848 by 848 pixels; color fundus image.
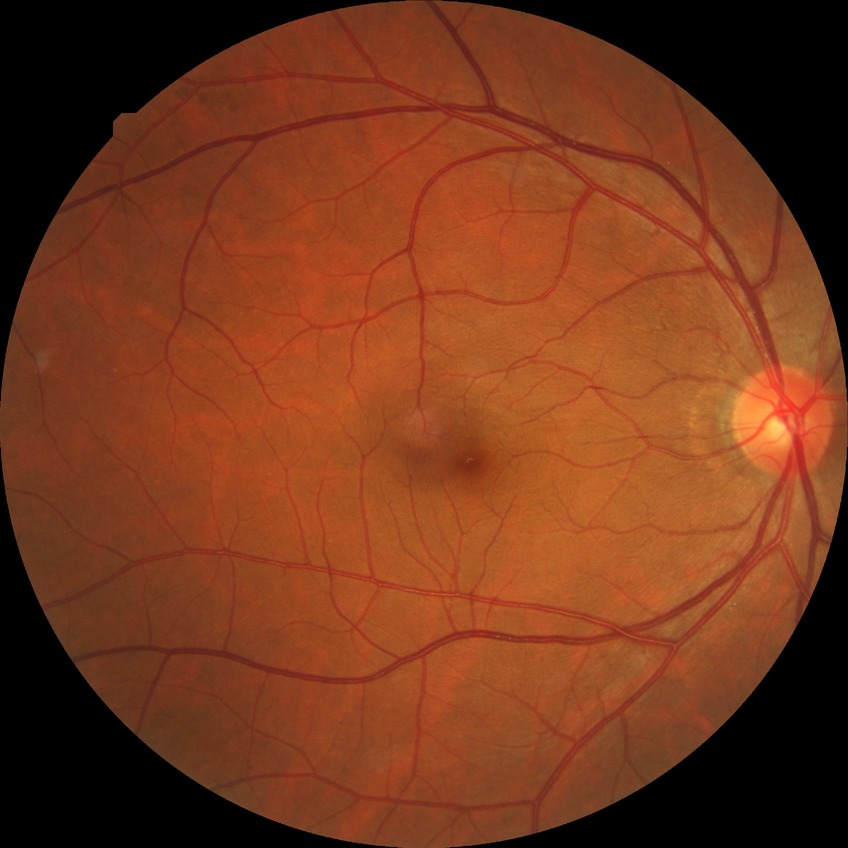
Diabetic retinopathy (DR): no diabetic retinopathy (NDR).